Fundus photo: 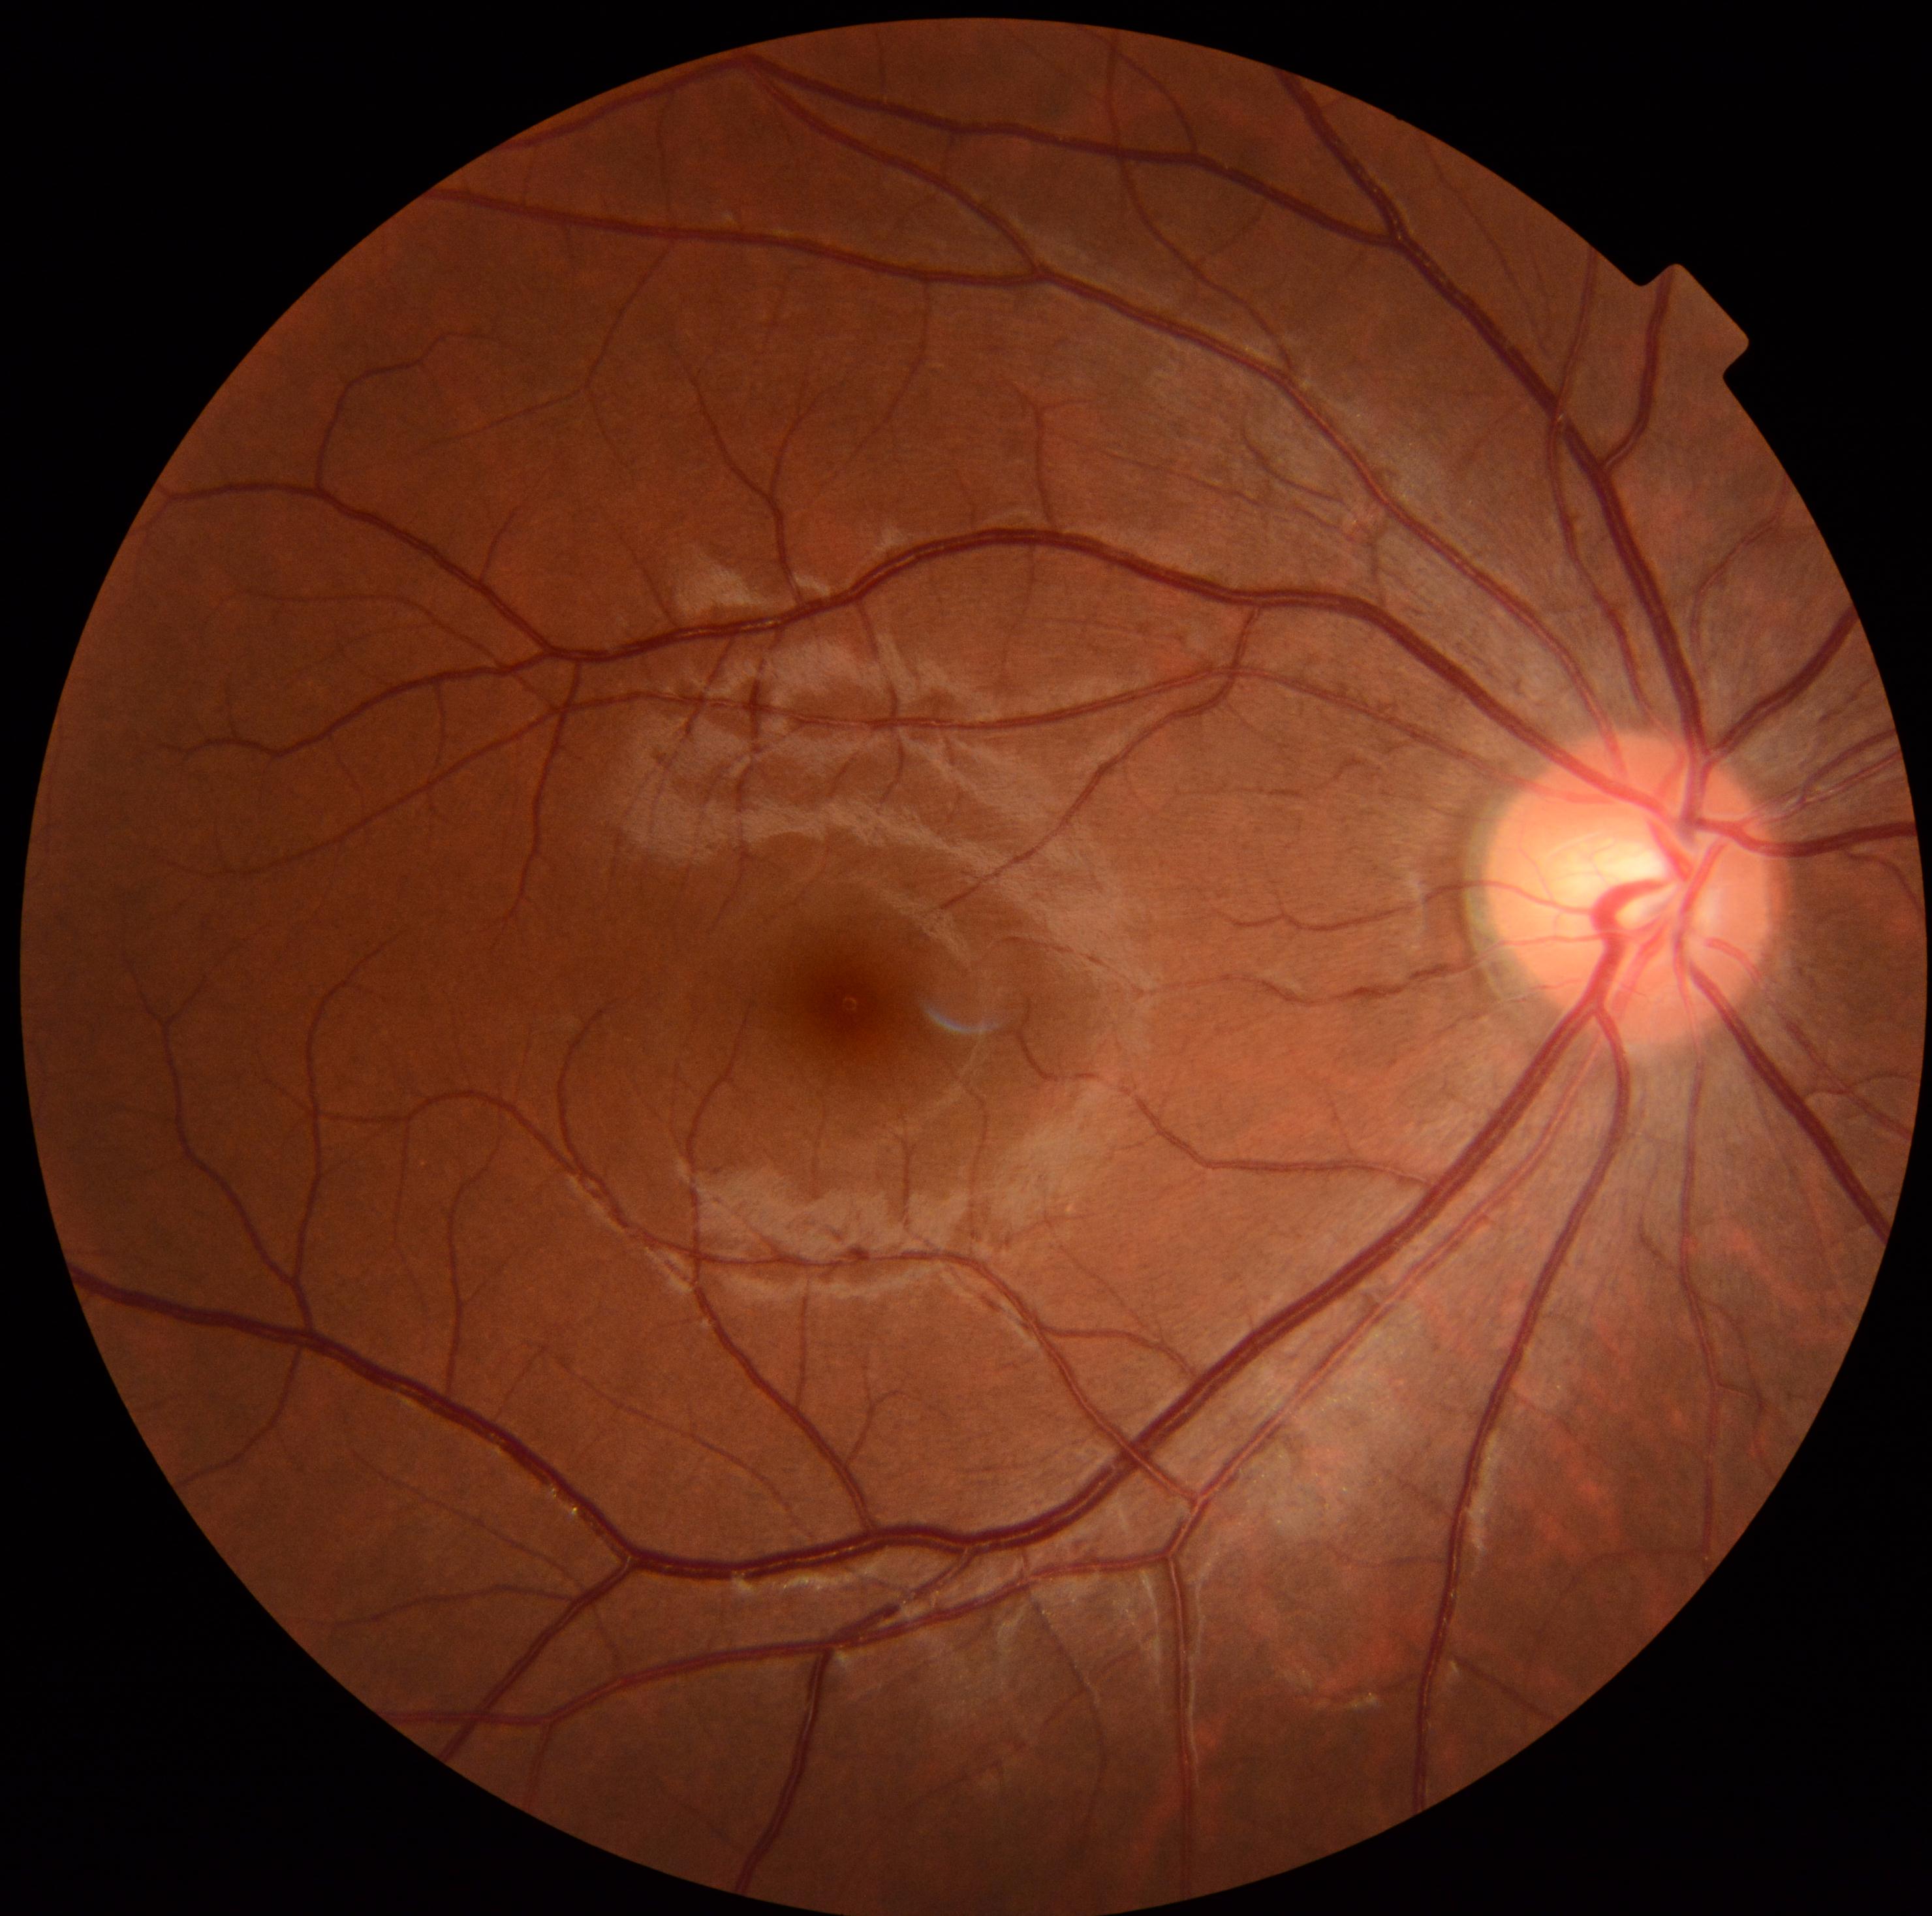
Retinopathy is grade 0.